848 by 848 pixels:
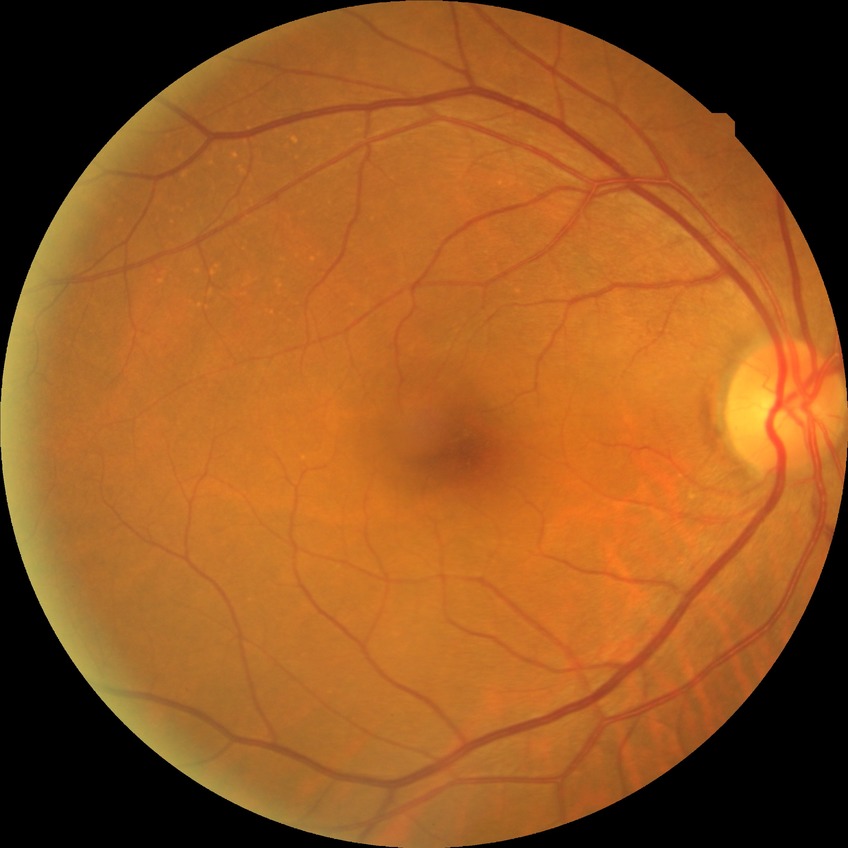

diabetic retinopathy (DR)@NDR (no diabetic retinopathy).